Fundus photo — 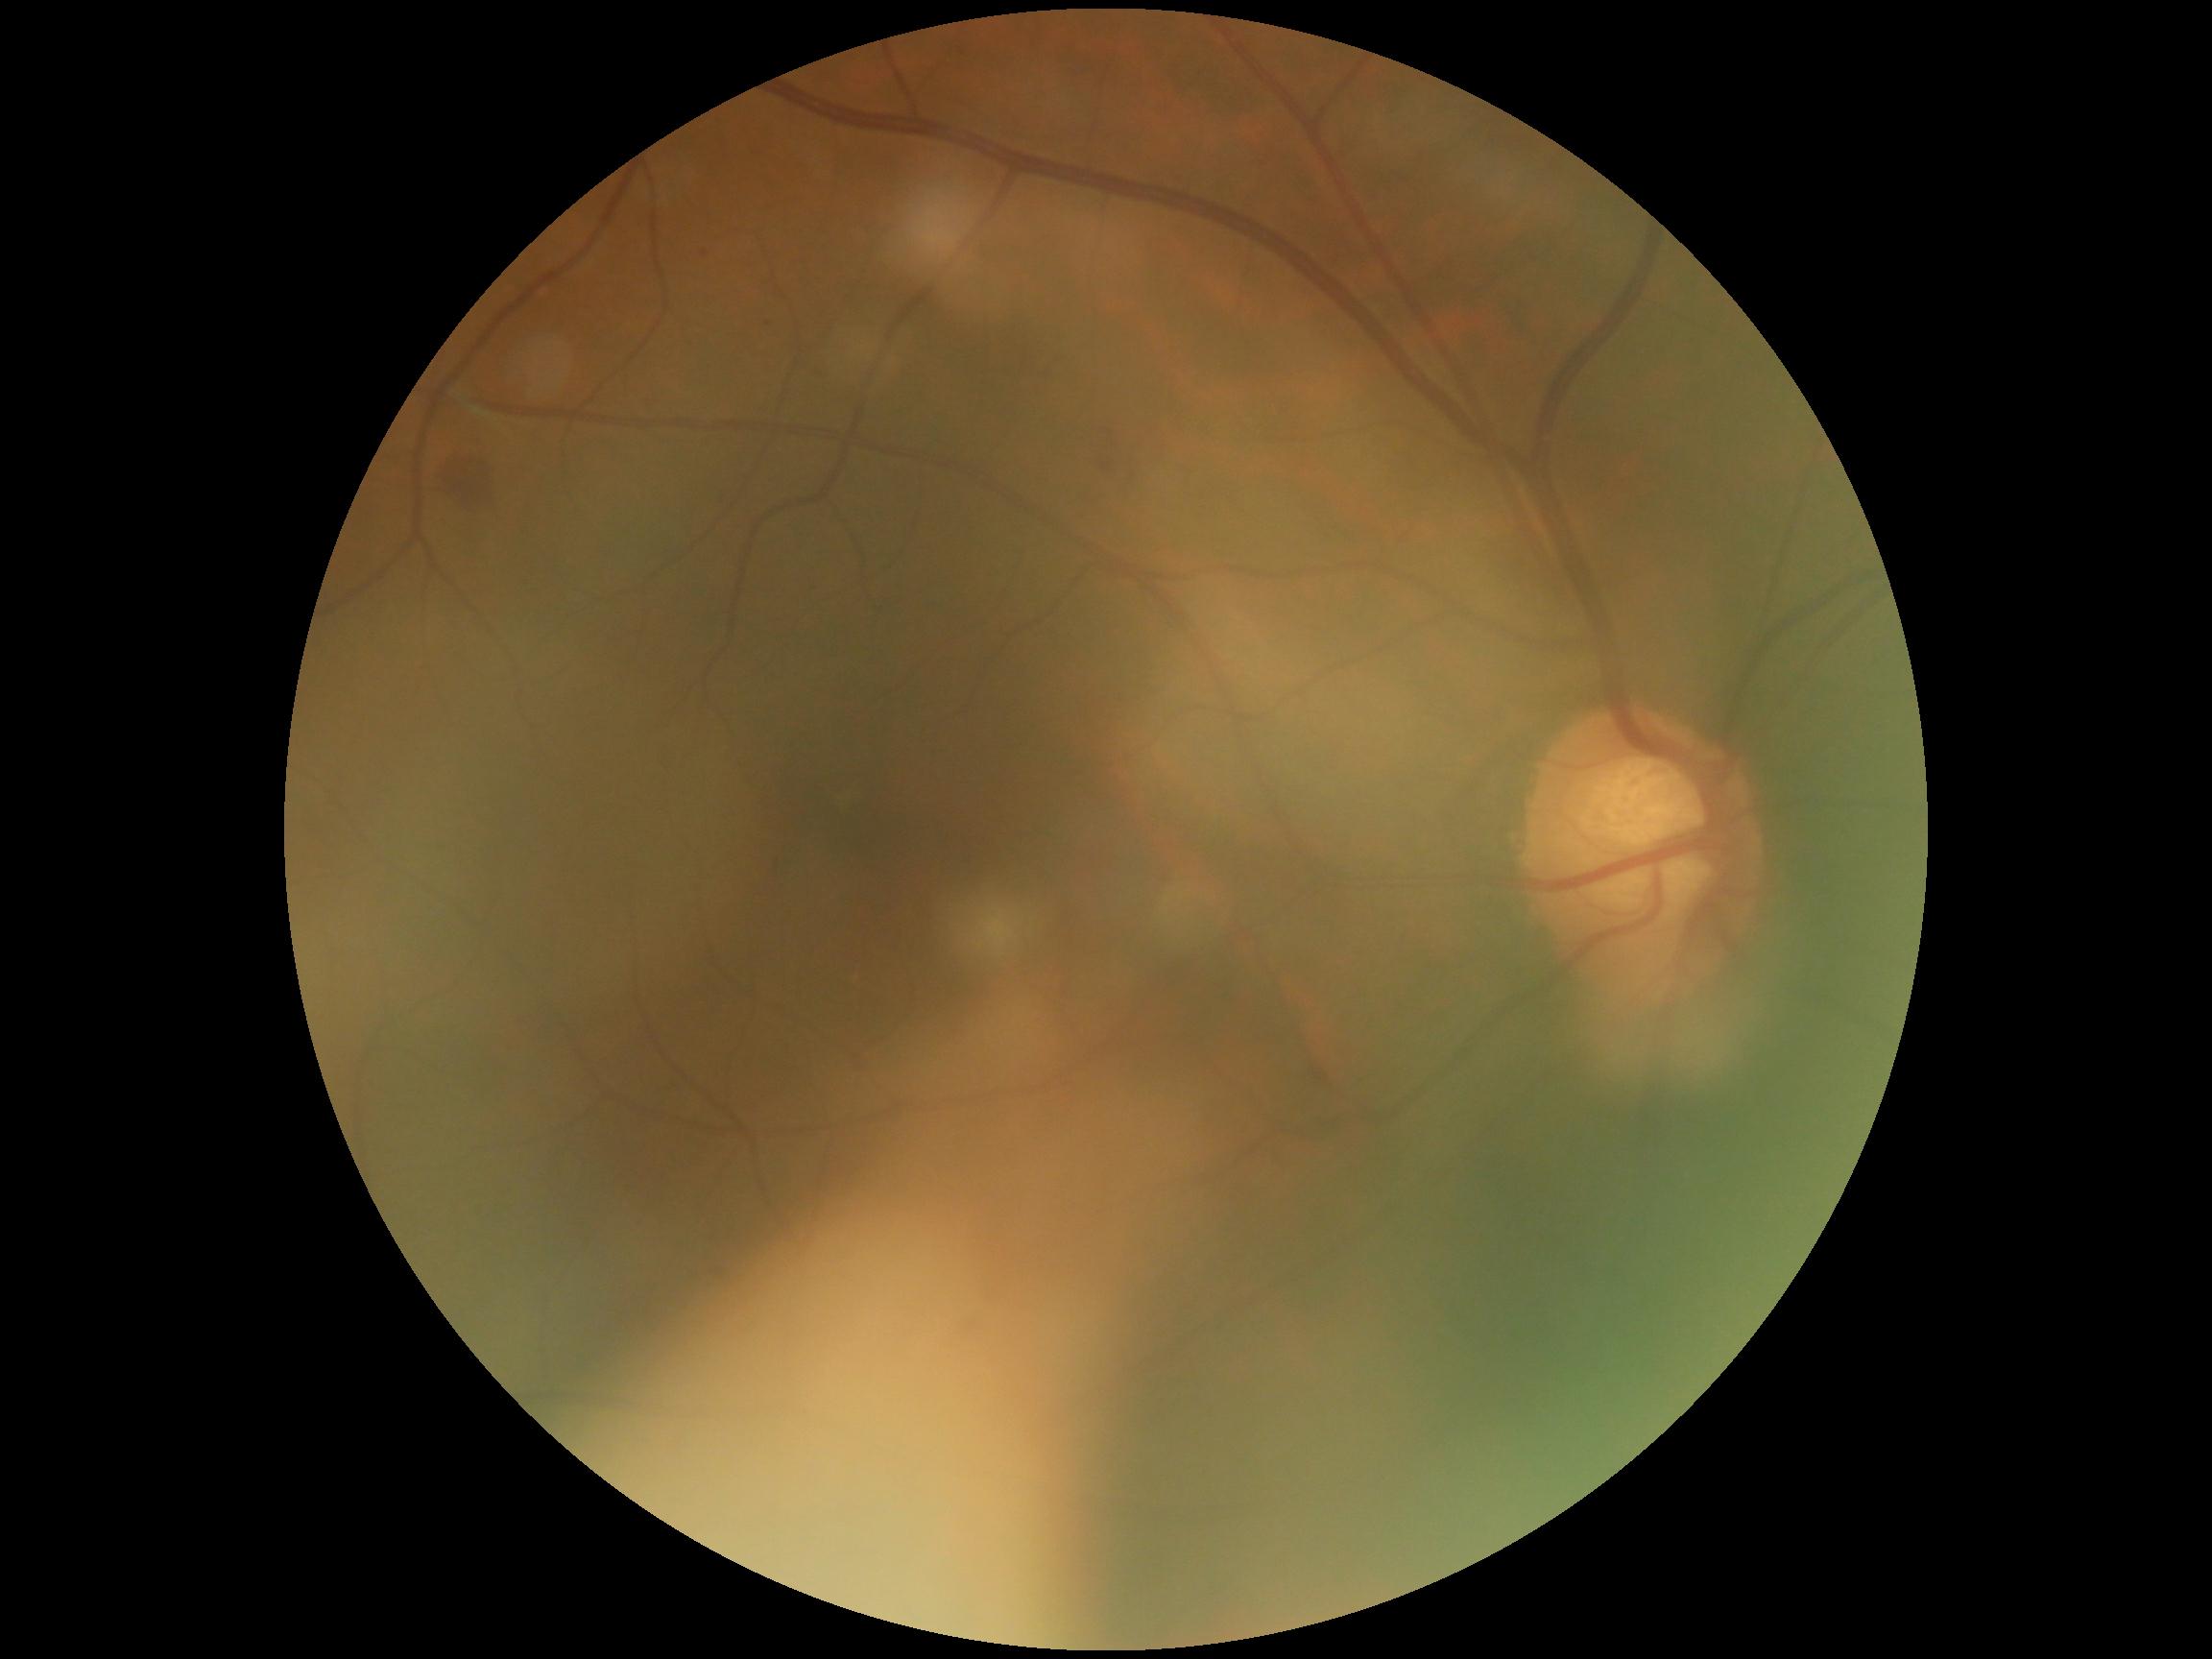
Disease class: non-proliferative diabetic retinopathy. Diabetic retinopathy (DR): moderate non-proliferative diabetic retinopathy (grade 2).